Diabetic retinopathy graded by the modified Davis classification — 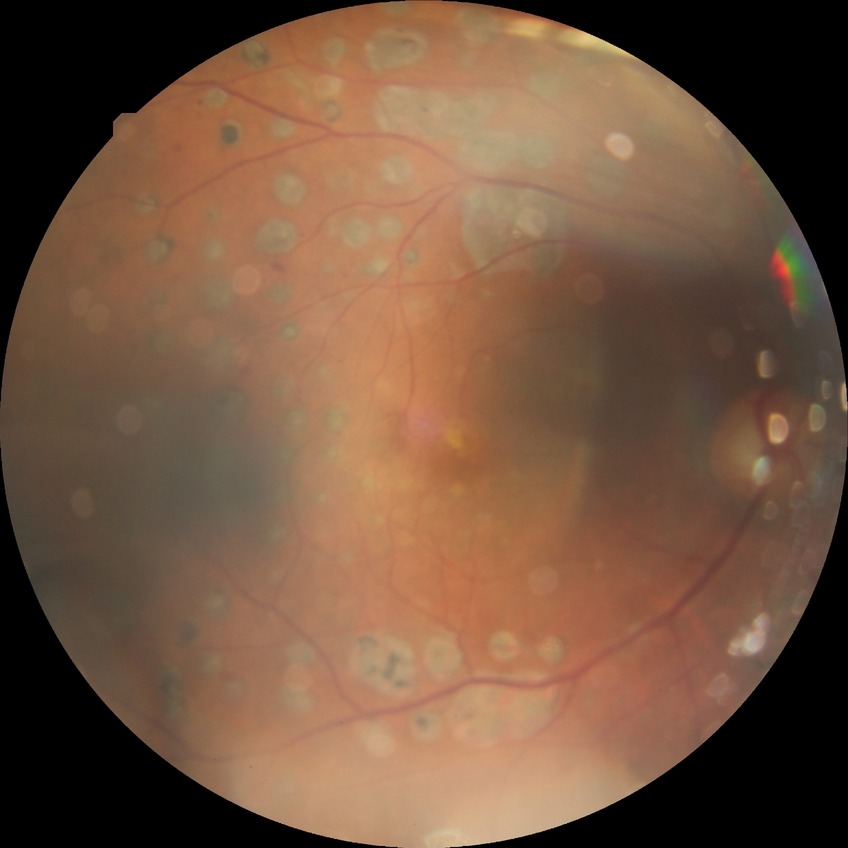
DR: PDR.